1240 by 1240 pixels. Pediatric wide-field fundus photograph — 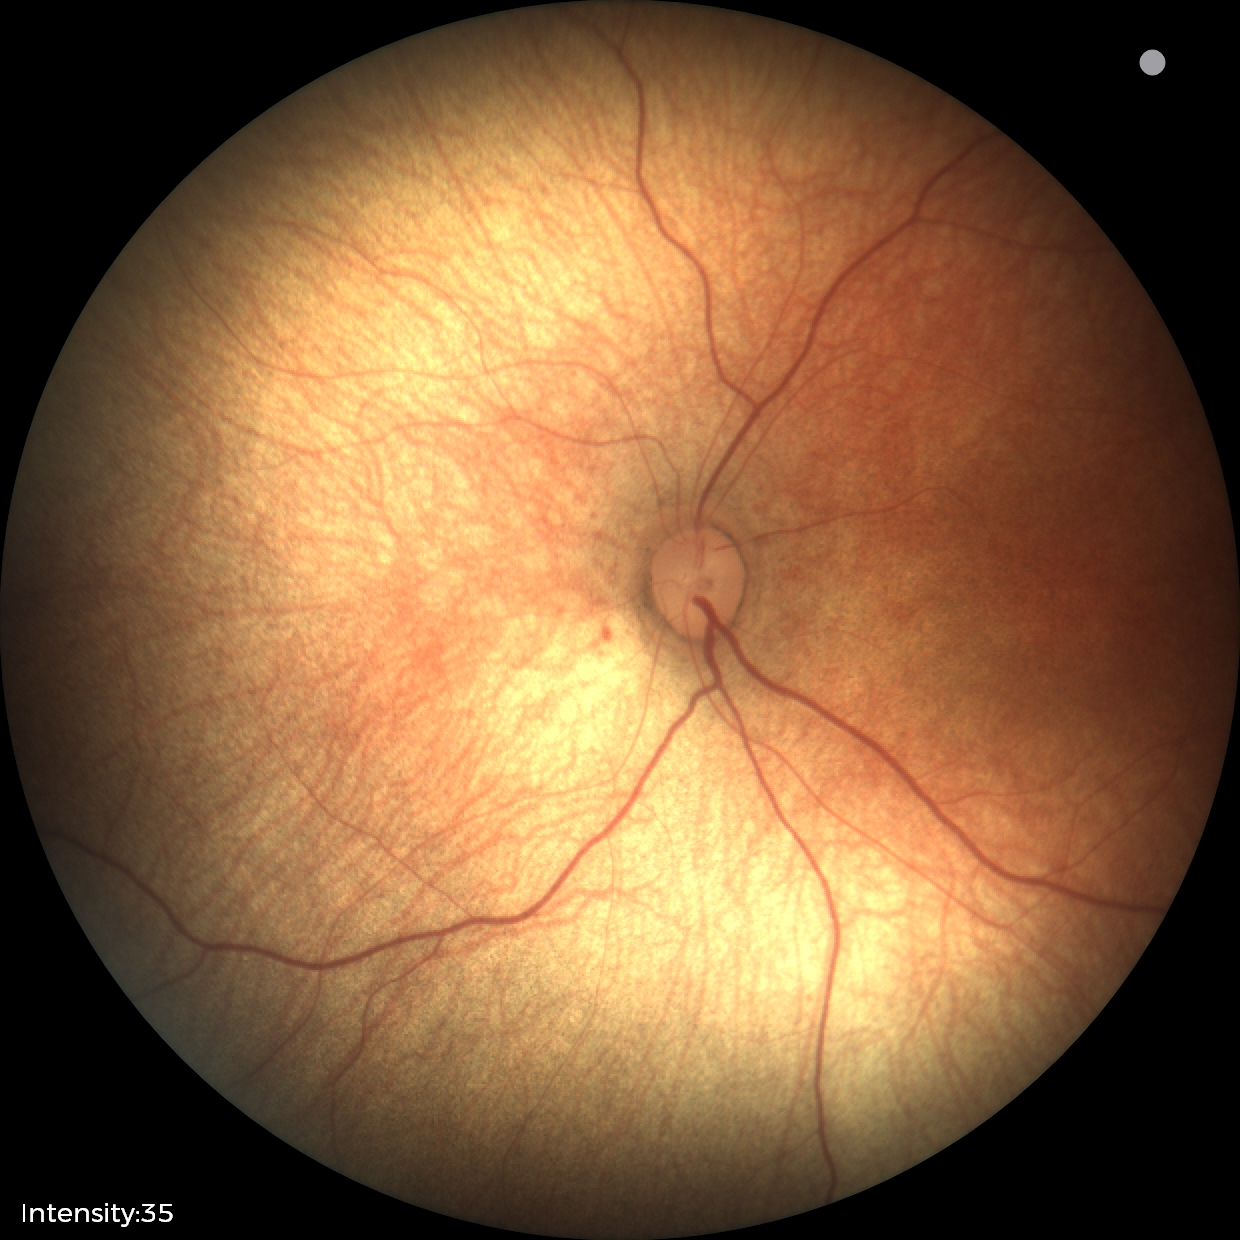
Physiological retinal appearance for postconceptual age.